Clarity RetCam 3, 130° FOV; 640x480; pediatric wide-field fundus photograph
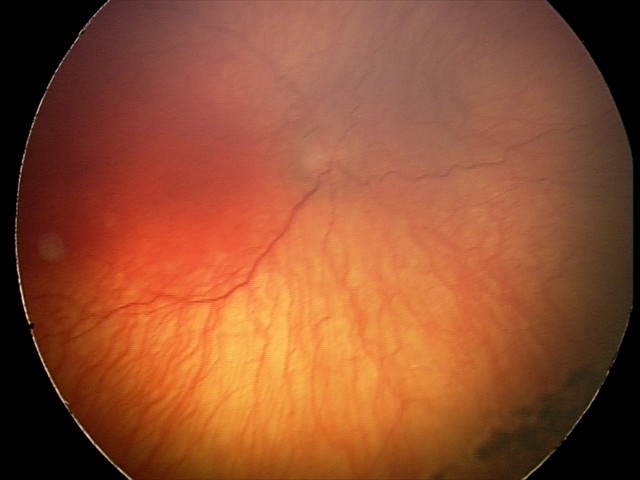

Screening series with aggressive retinopathy of prematurity.